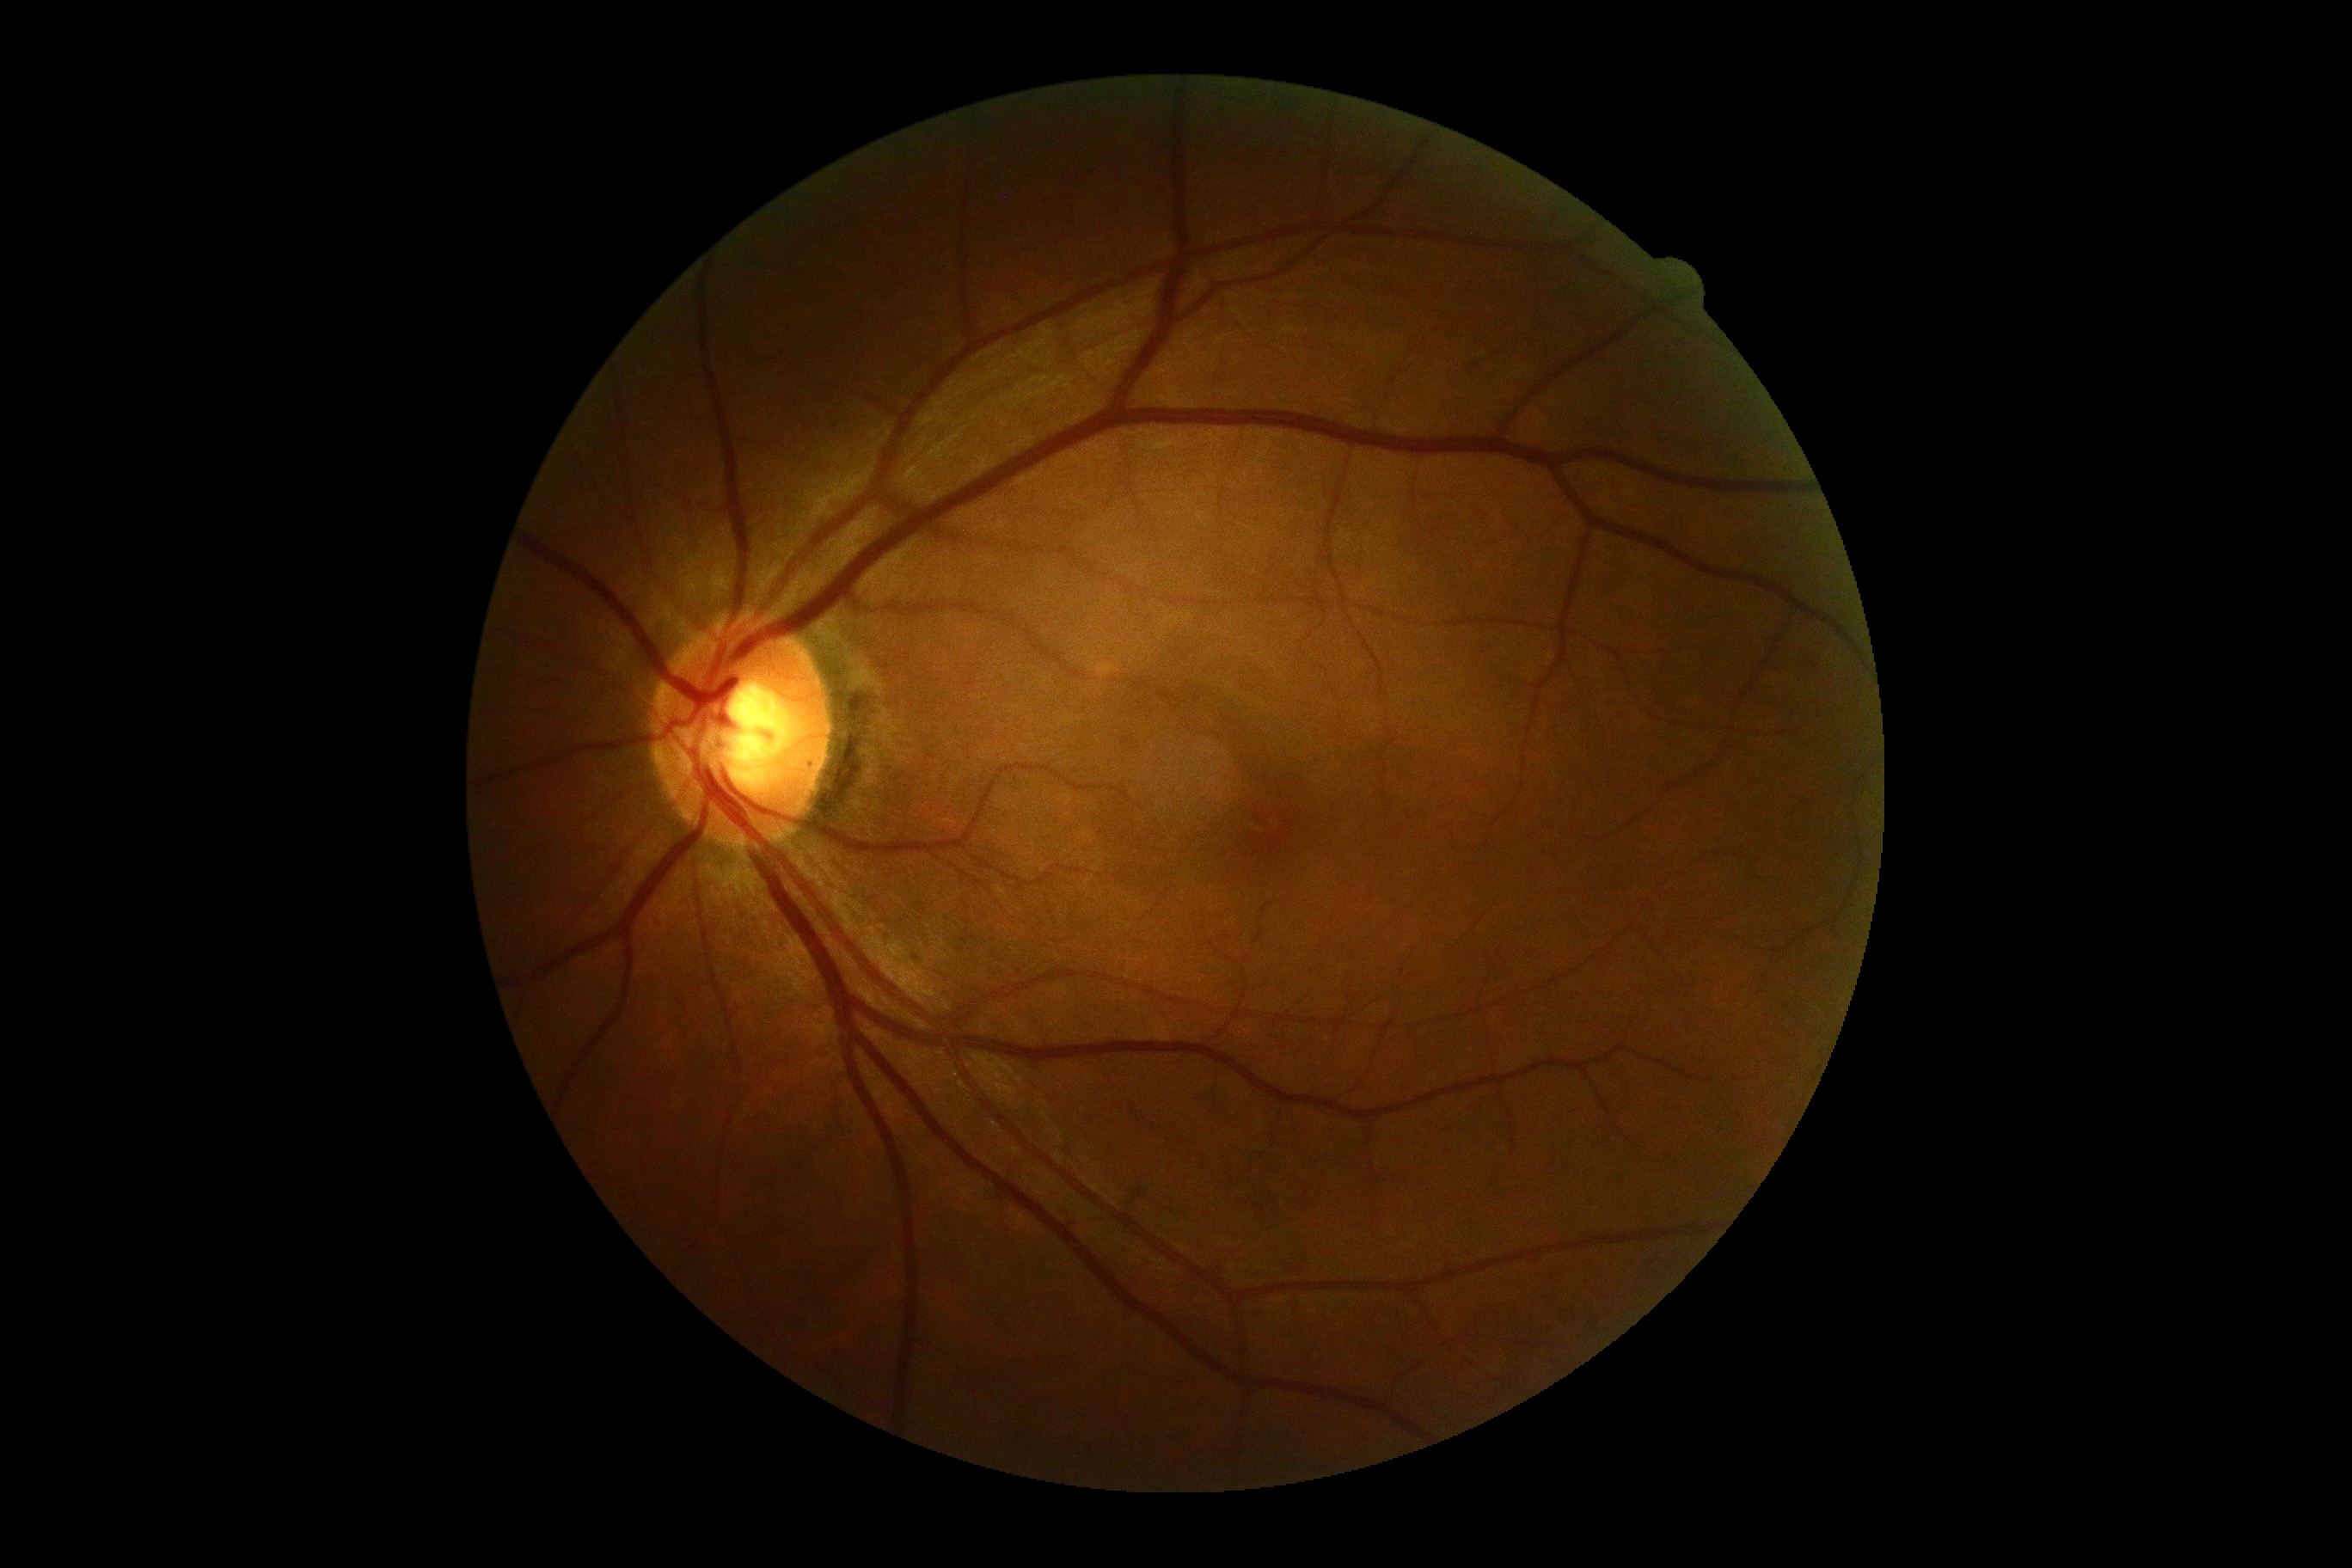
DR severity is 0/4. No diabetic retinal disease findings.